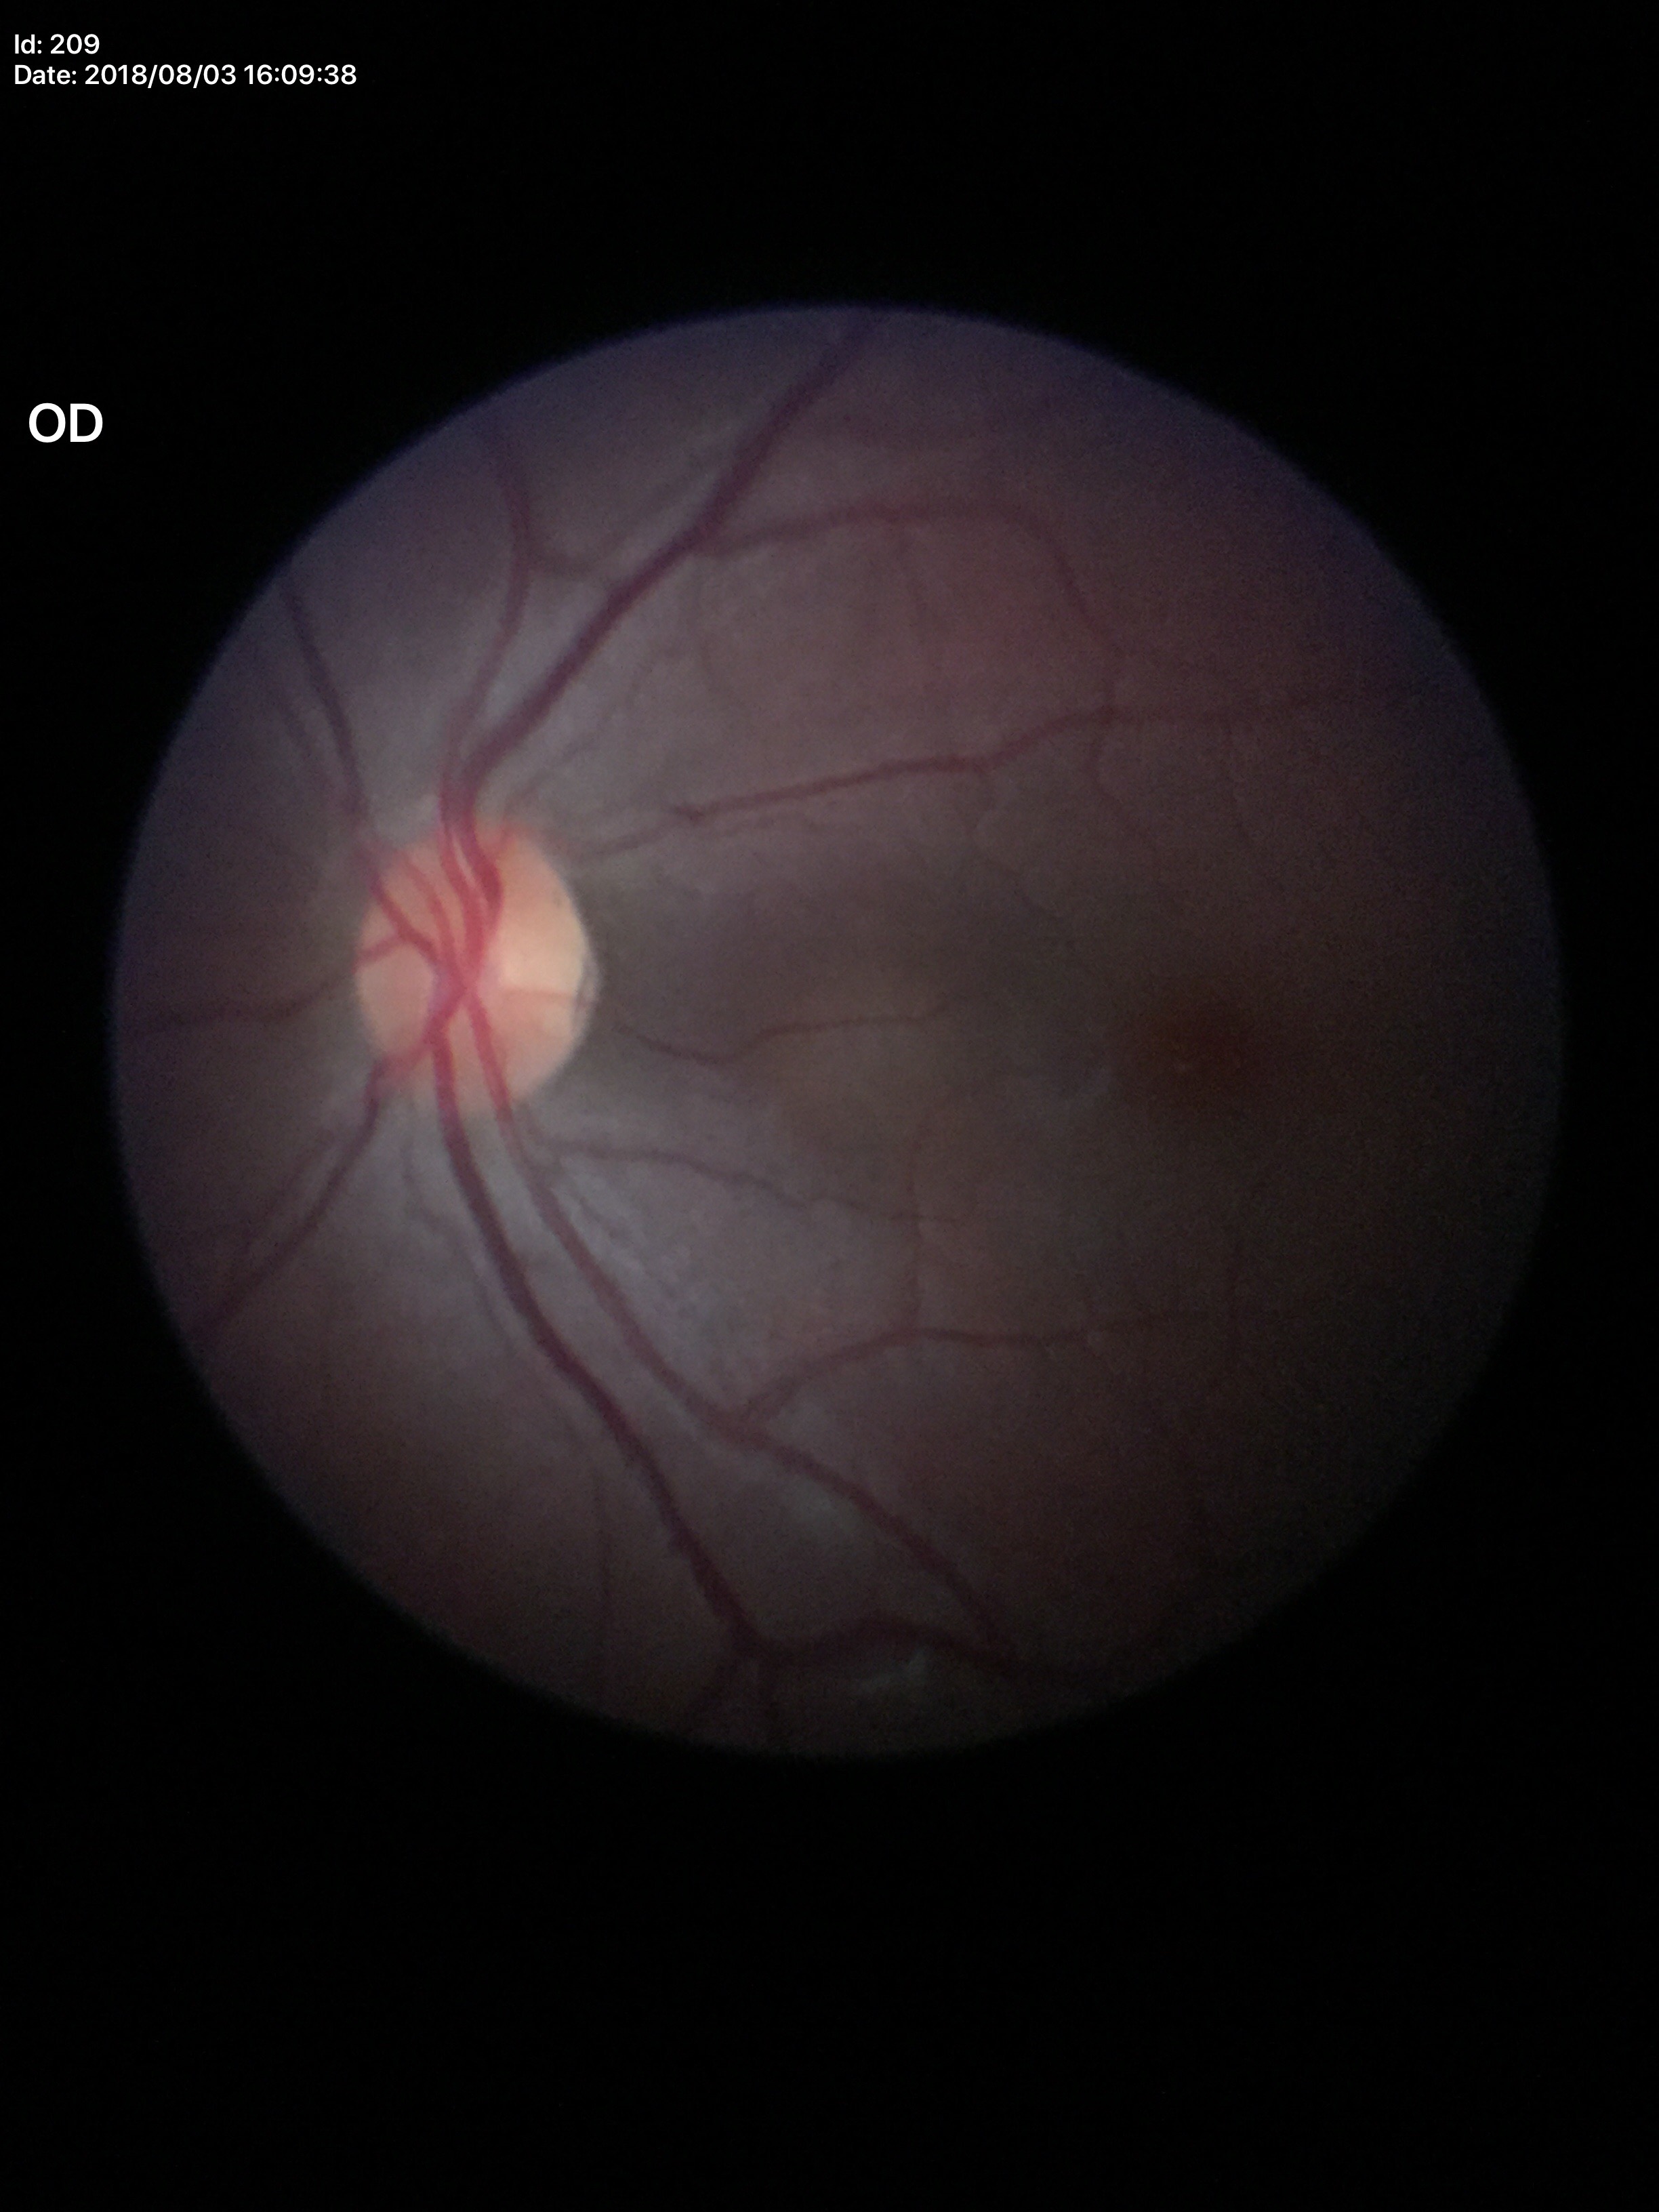

Vertical cup-disc ratio (VCDR): 0.46. No evidence of glaucoma (5/5 ophthalmologists in agreement).